100° field of view (Phoenix ICON). Phoenix ICON wide-field infant fundus image
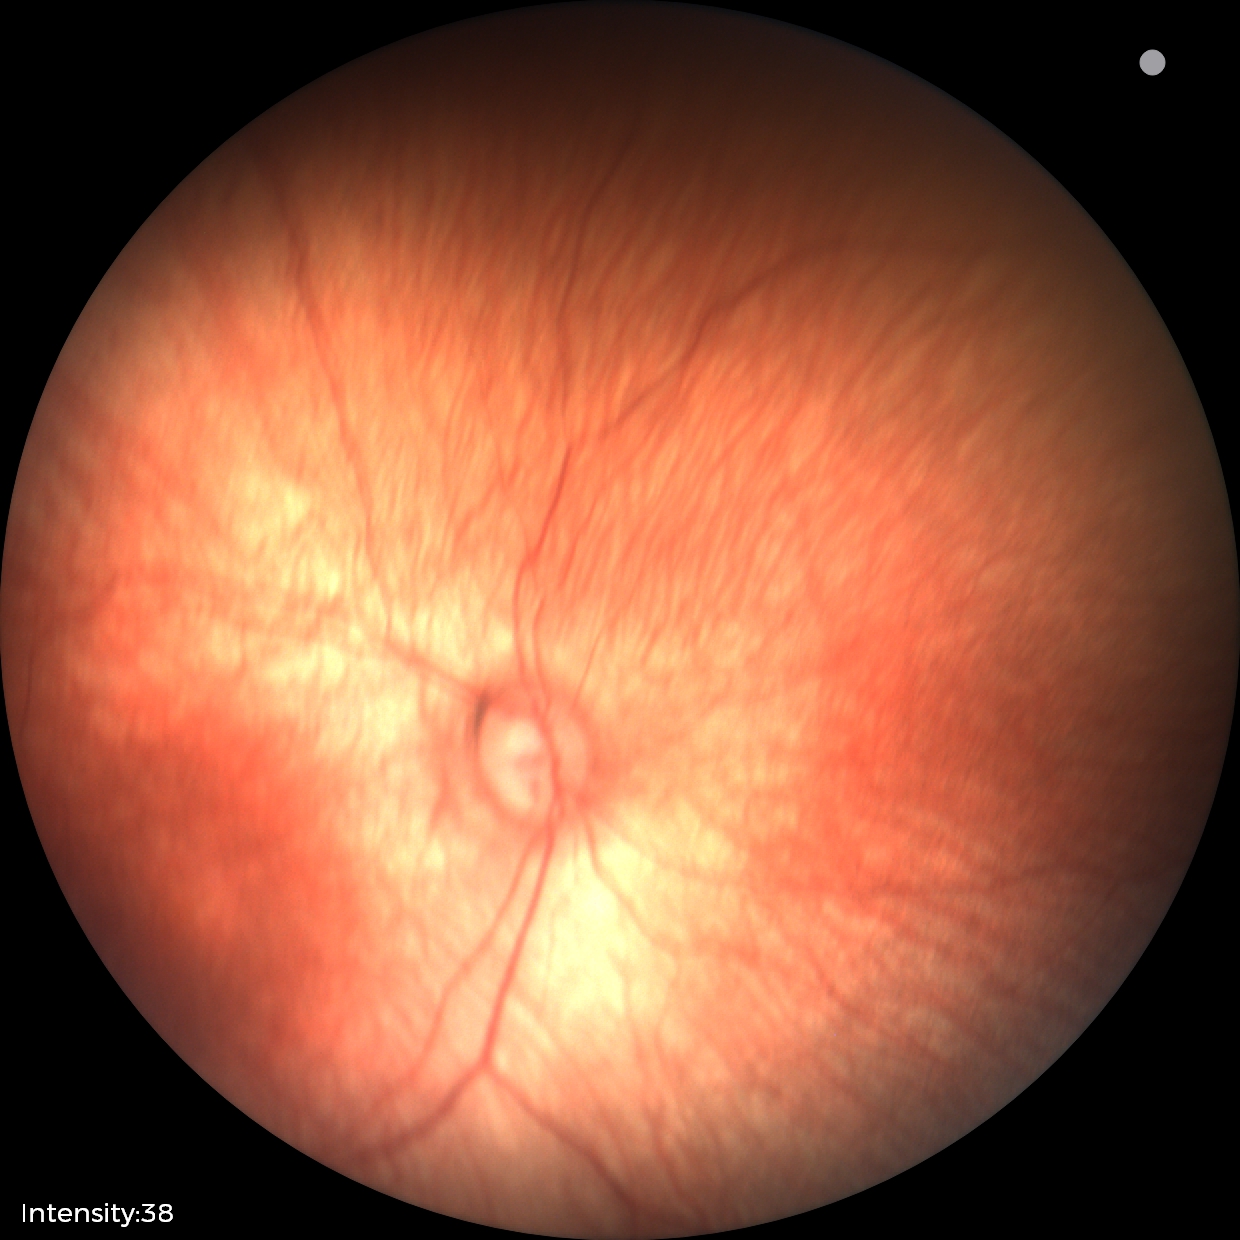

Examination with physiological retinal findings.